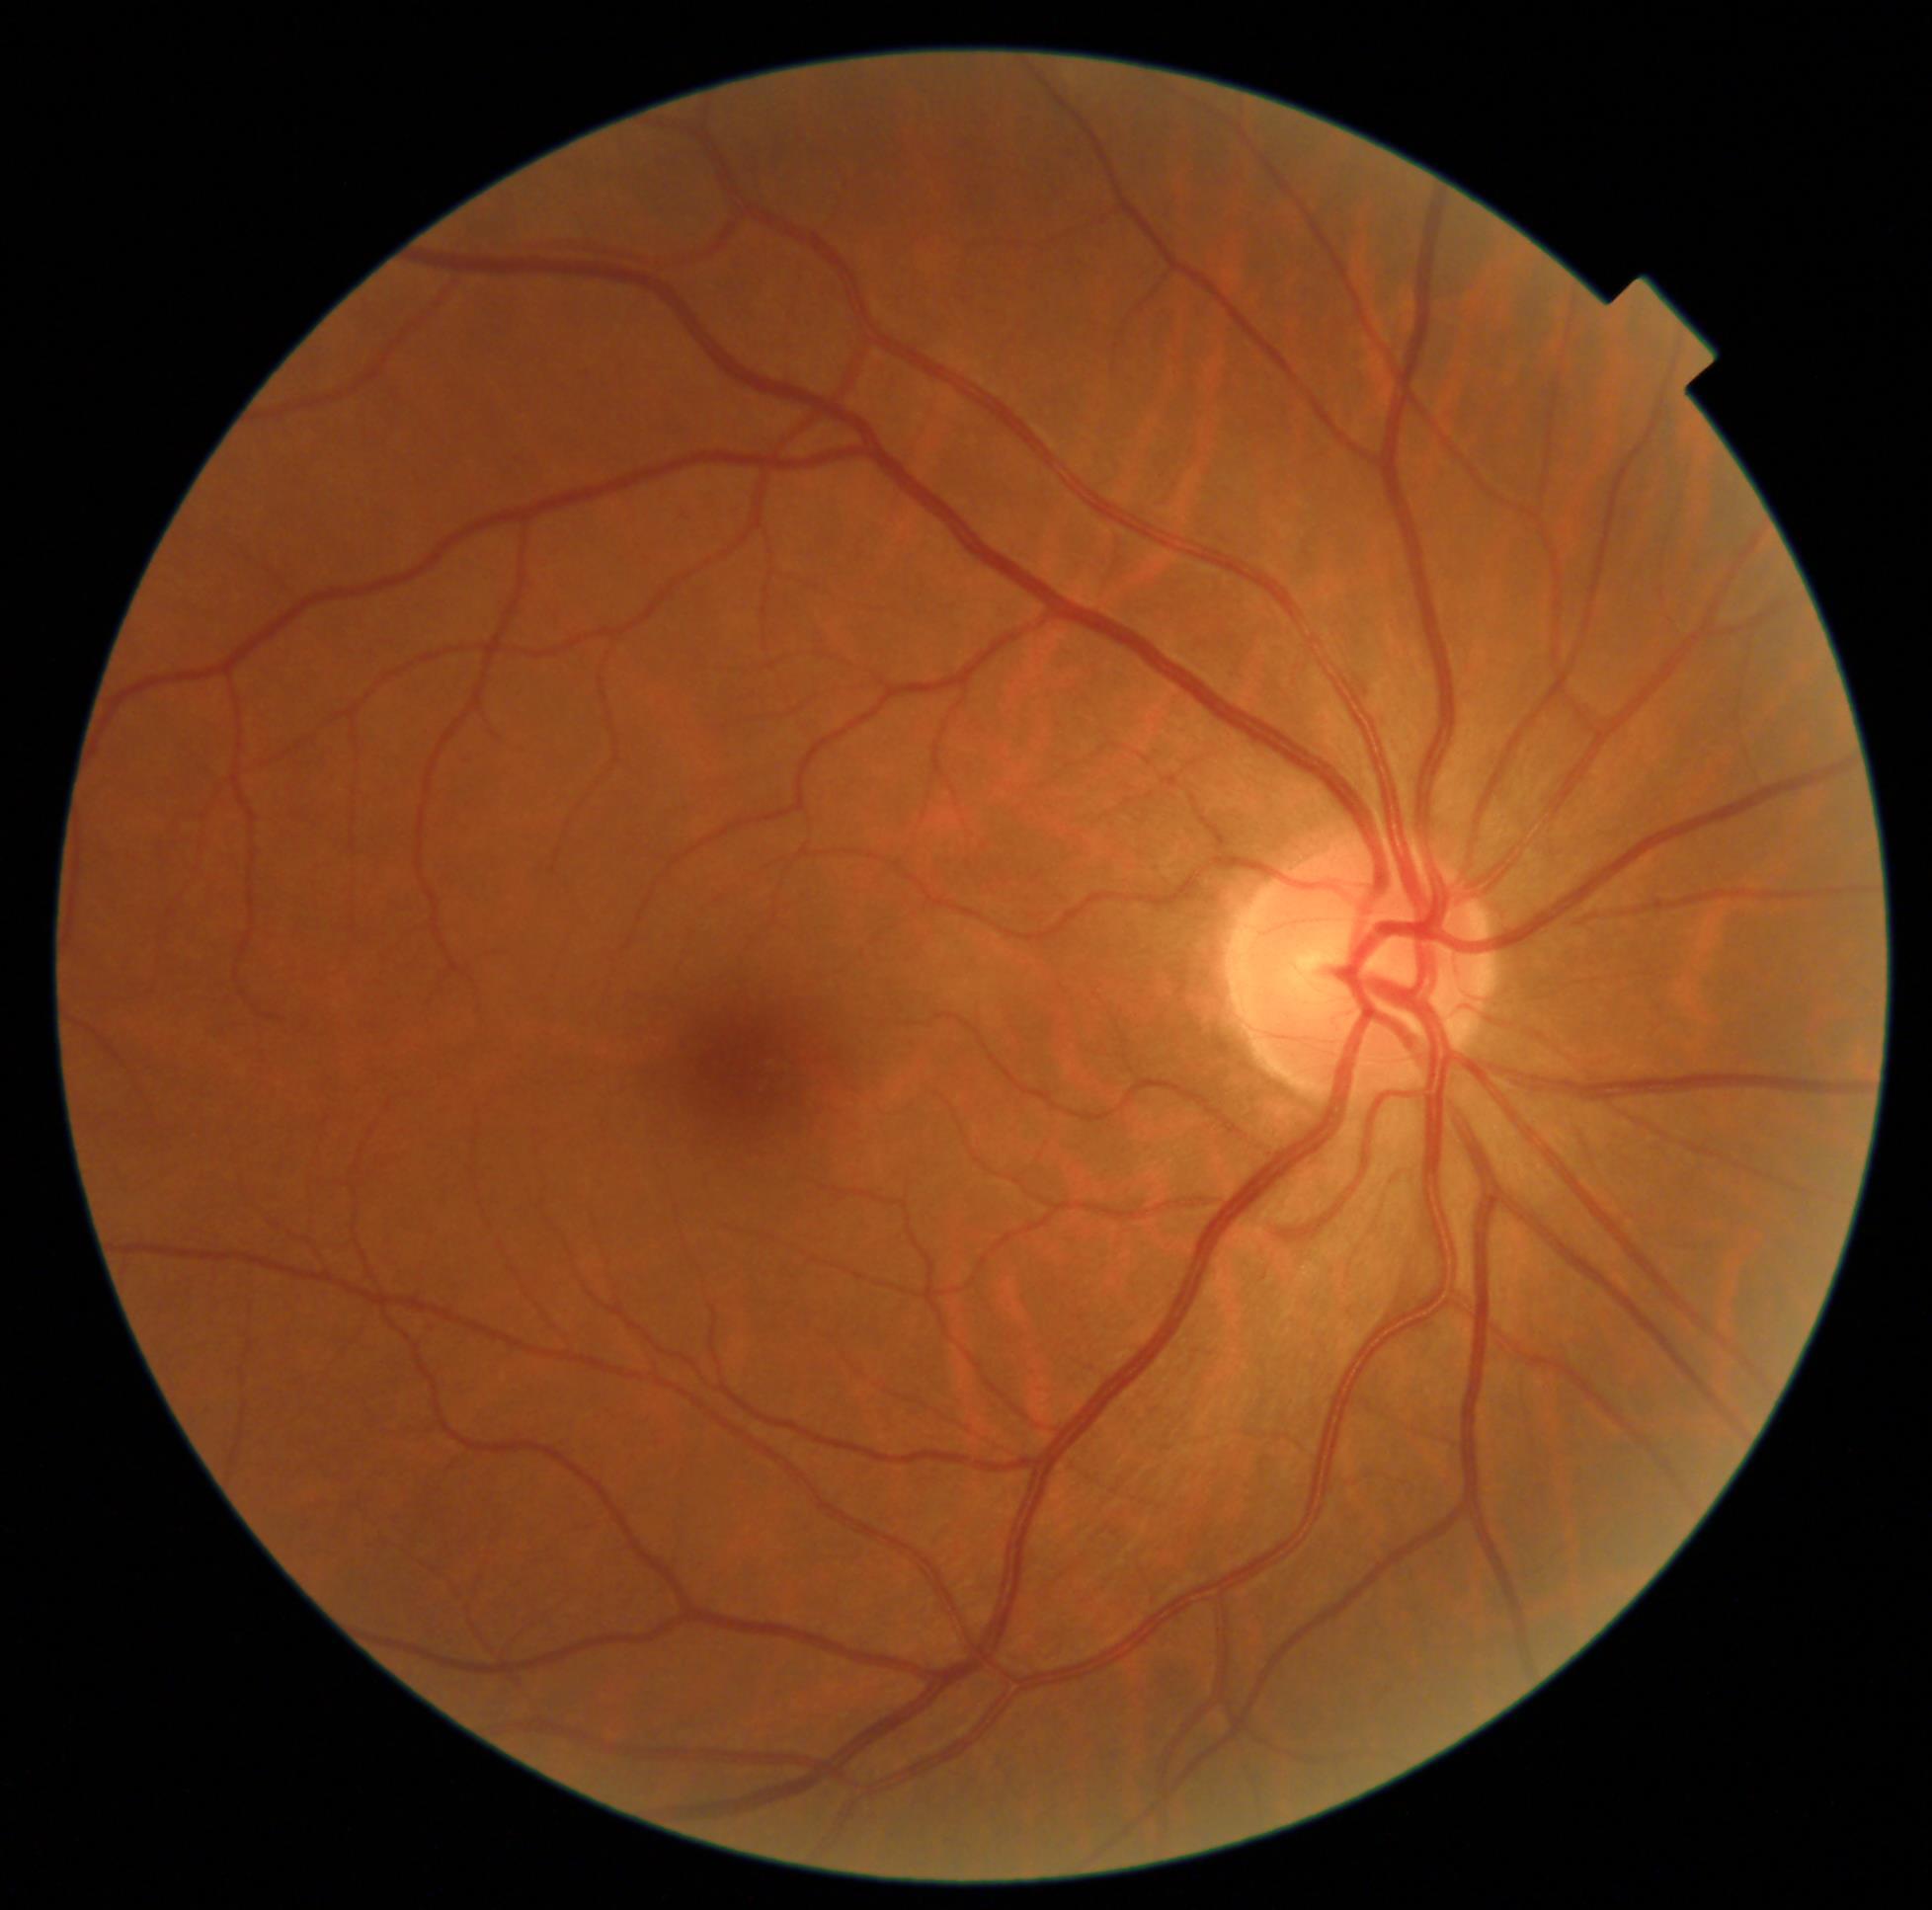 Findings:
* DR grade: no apparent diabetic retinopathy (0)